Wide-field fundus image from infant ROP screening.
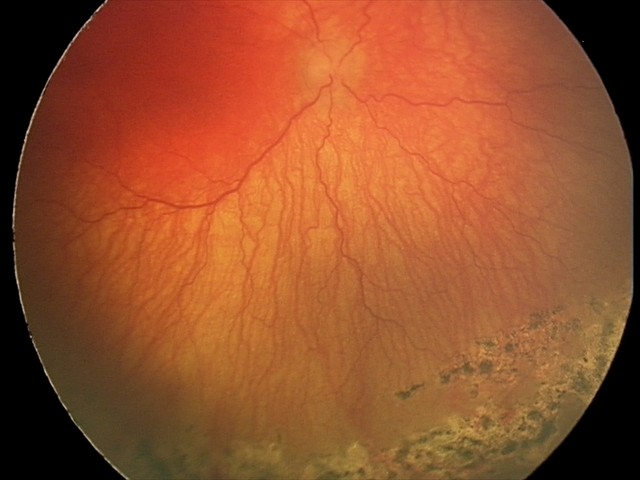

Q: What is the screening diagnosis?
A: A-ROP (aggressive ROP)
Q: Is plus disease present?
A: plus disease